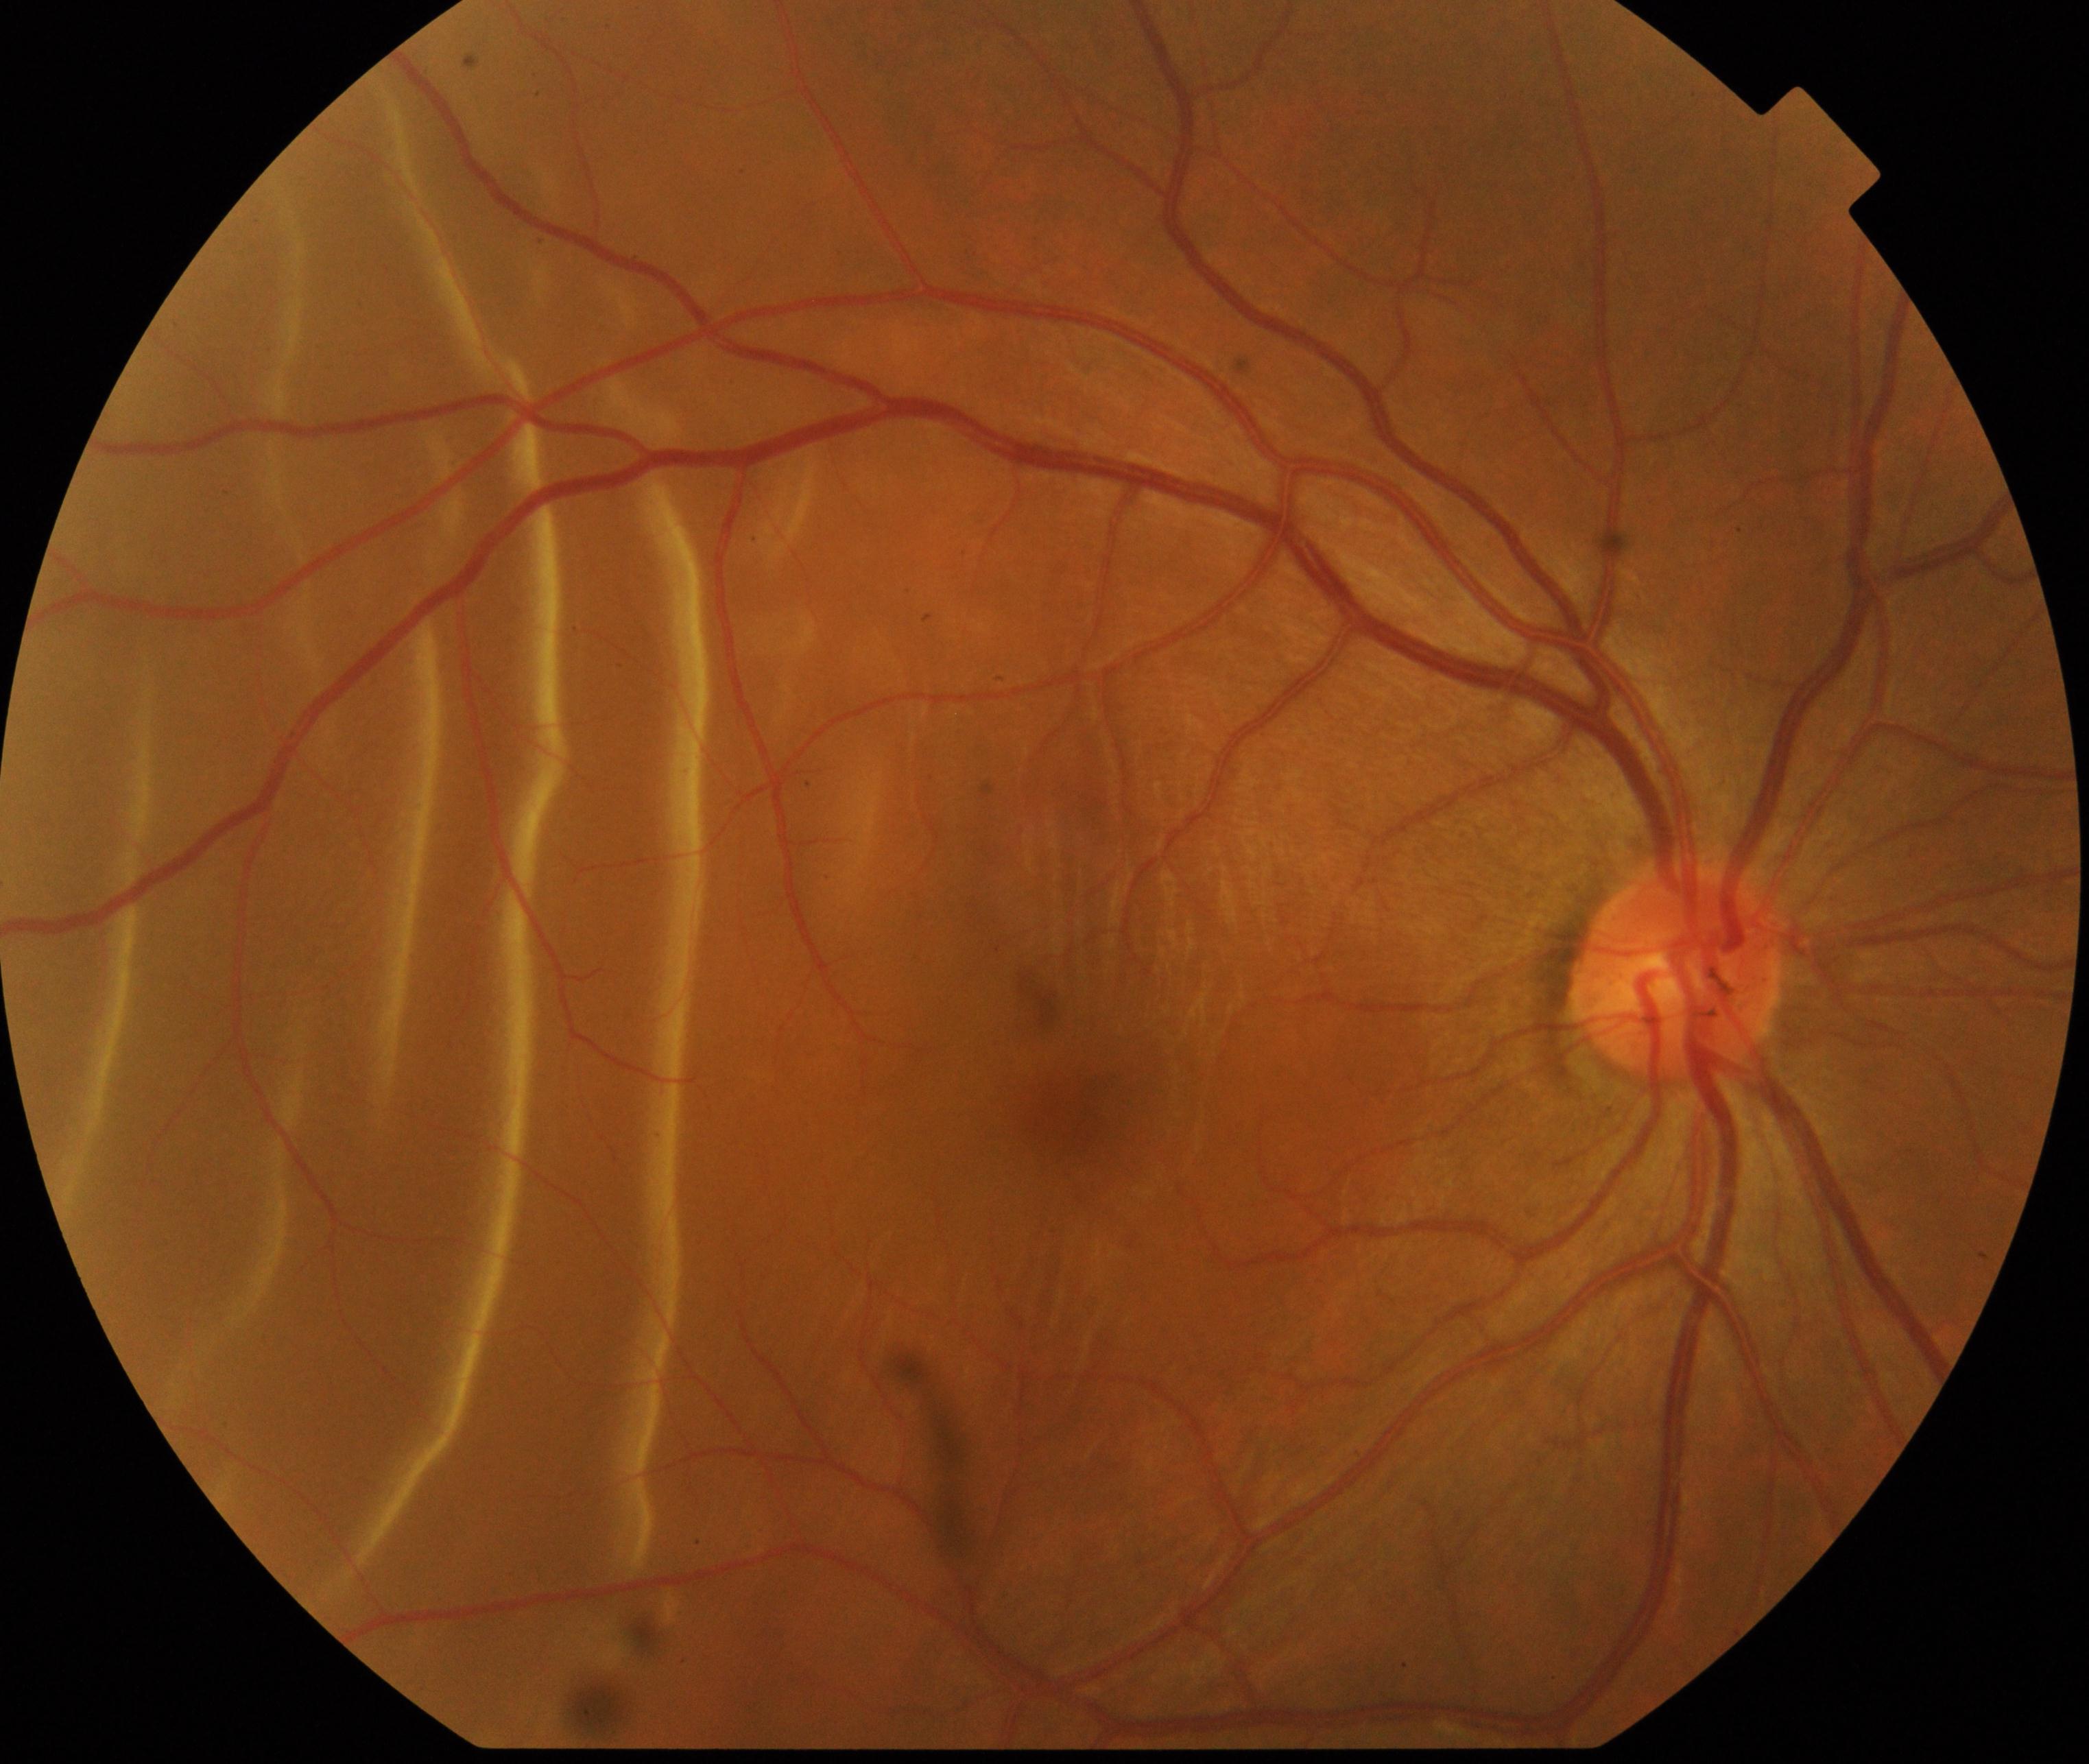

Classification: rhegmatogenous retinal detachment. Typically showing slightly opaque, convex or corrugated appearance of elevated retina, sometimes with retinal breaks in view.